200° field of view; wide-field retinal mosaic image — 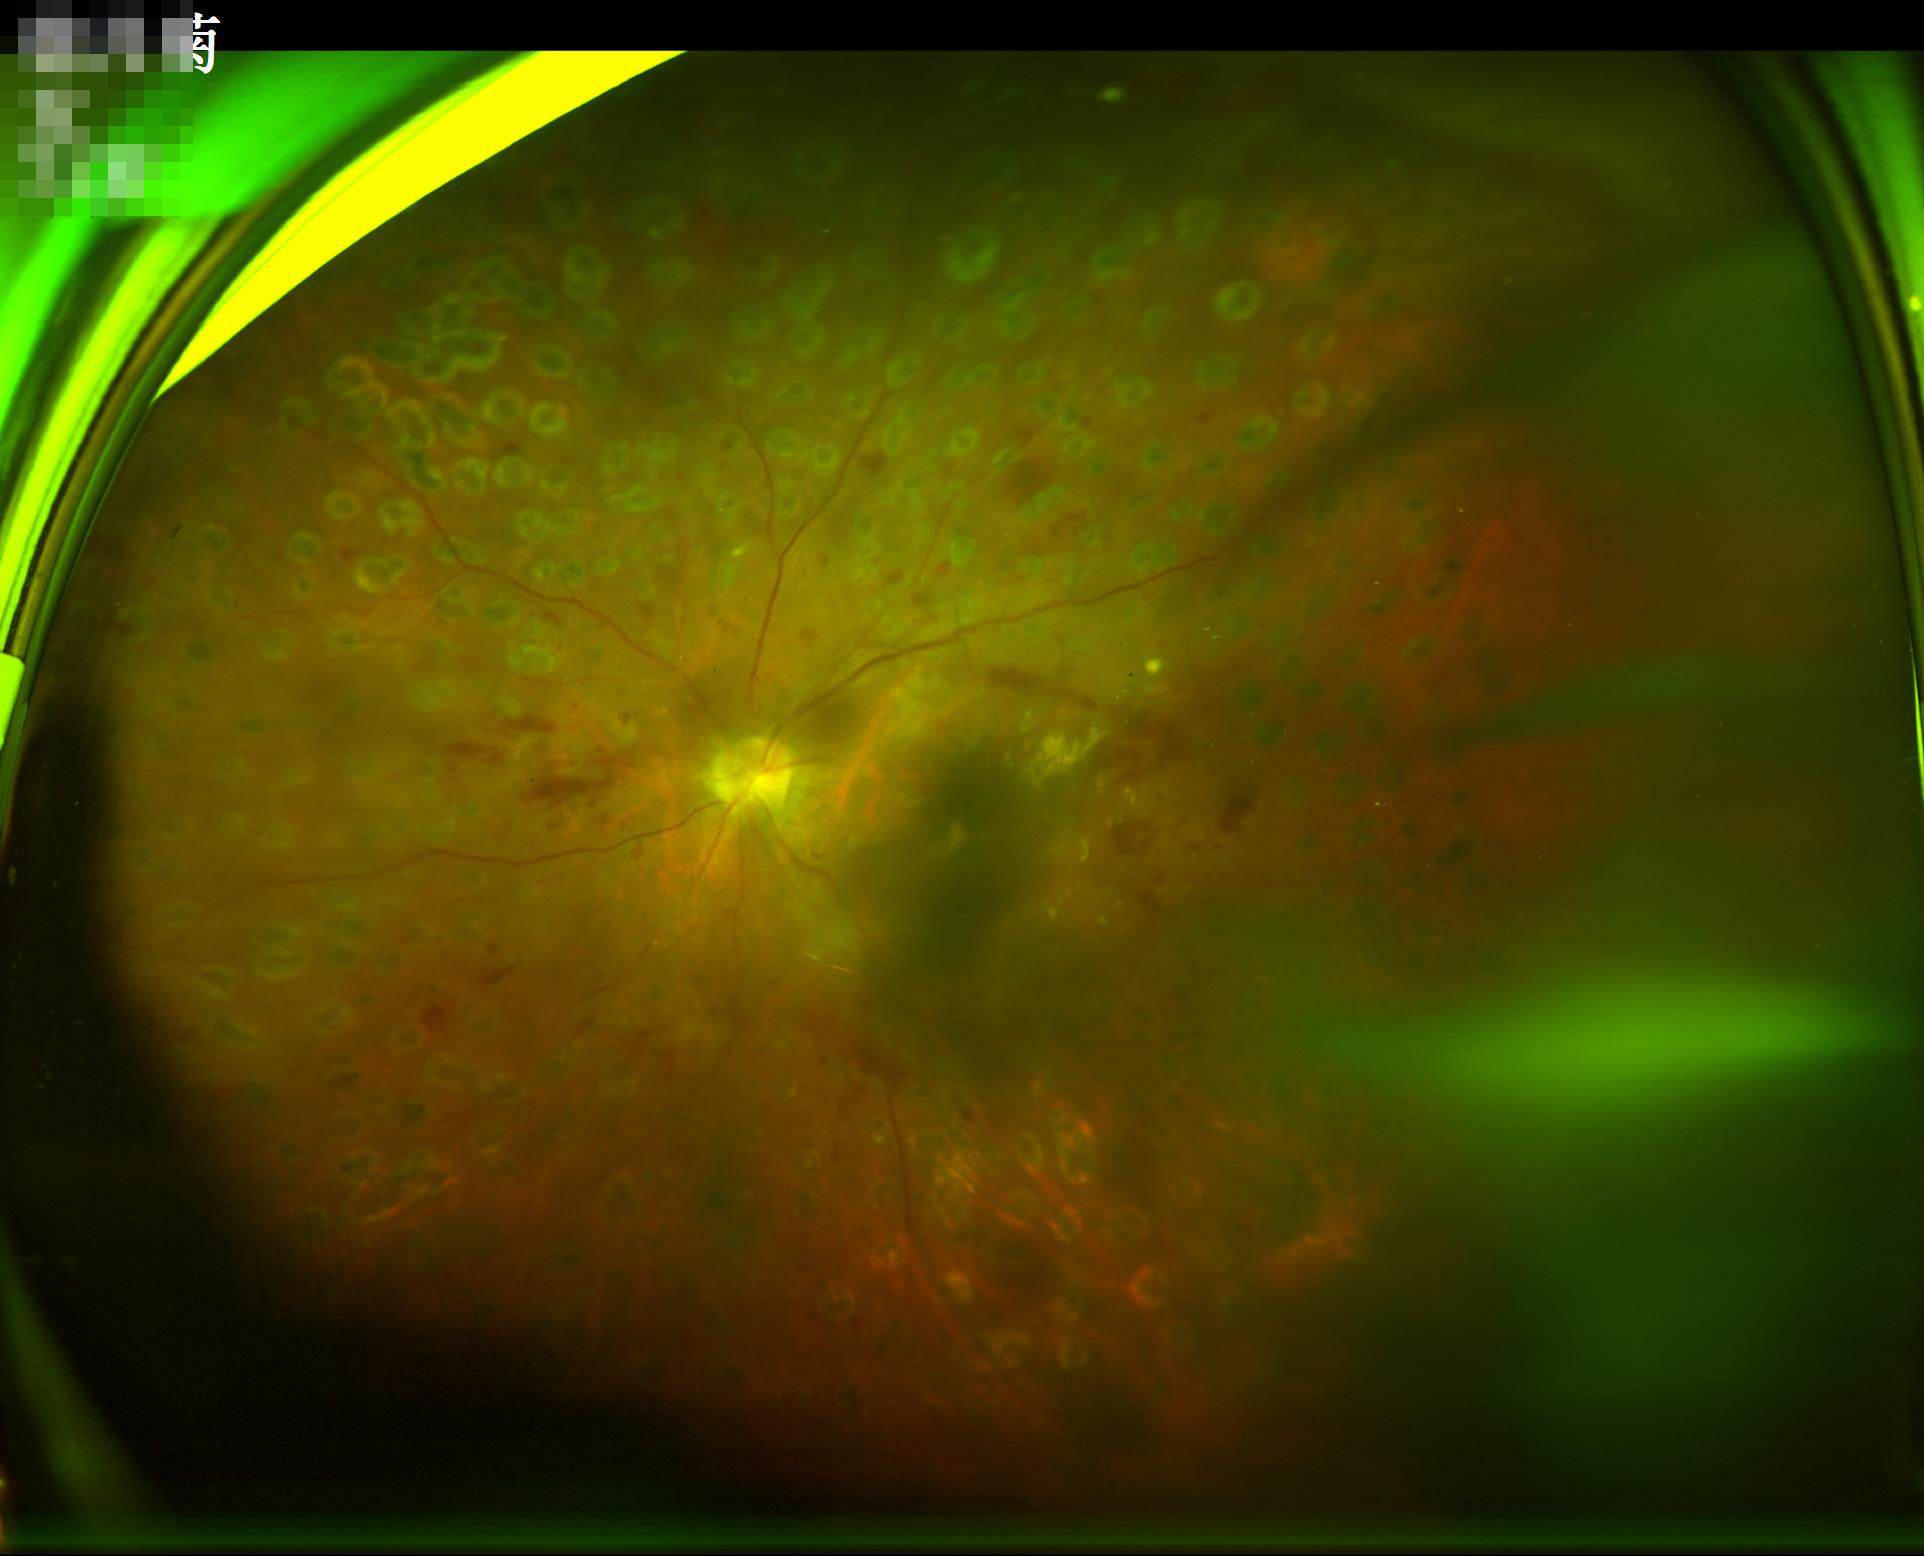 Overall image quality: poor, ungradable; Illumination: inadequate, with uneven exposure or color distortion; Sharpness: reduced sharpness with visible blur; Contrast: wide intensity range, structures distinguishable.